Color fundus image.
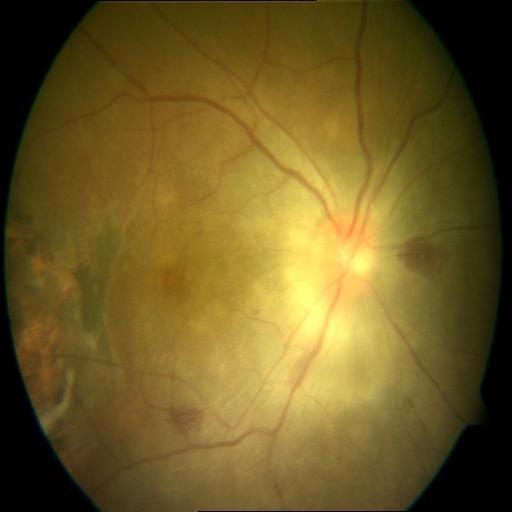 2 abnormalities. Findings consistent with macular scar (MS) & hemorrhagic retinopathy (HR).